Camera: Phoenix ICON (100° FOV). Pediatric retinal photograph (wide-field):
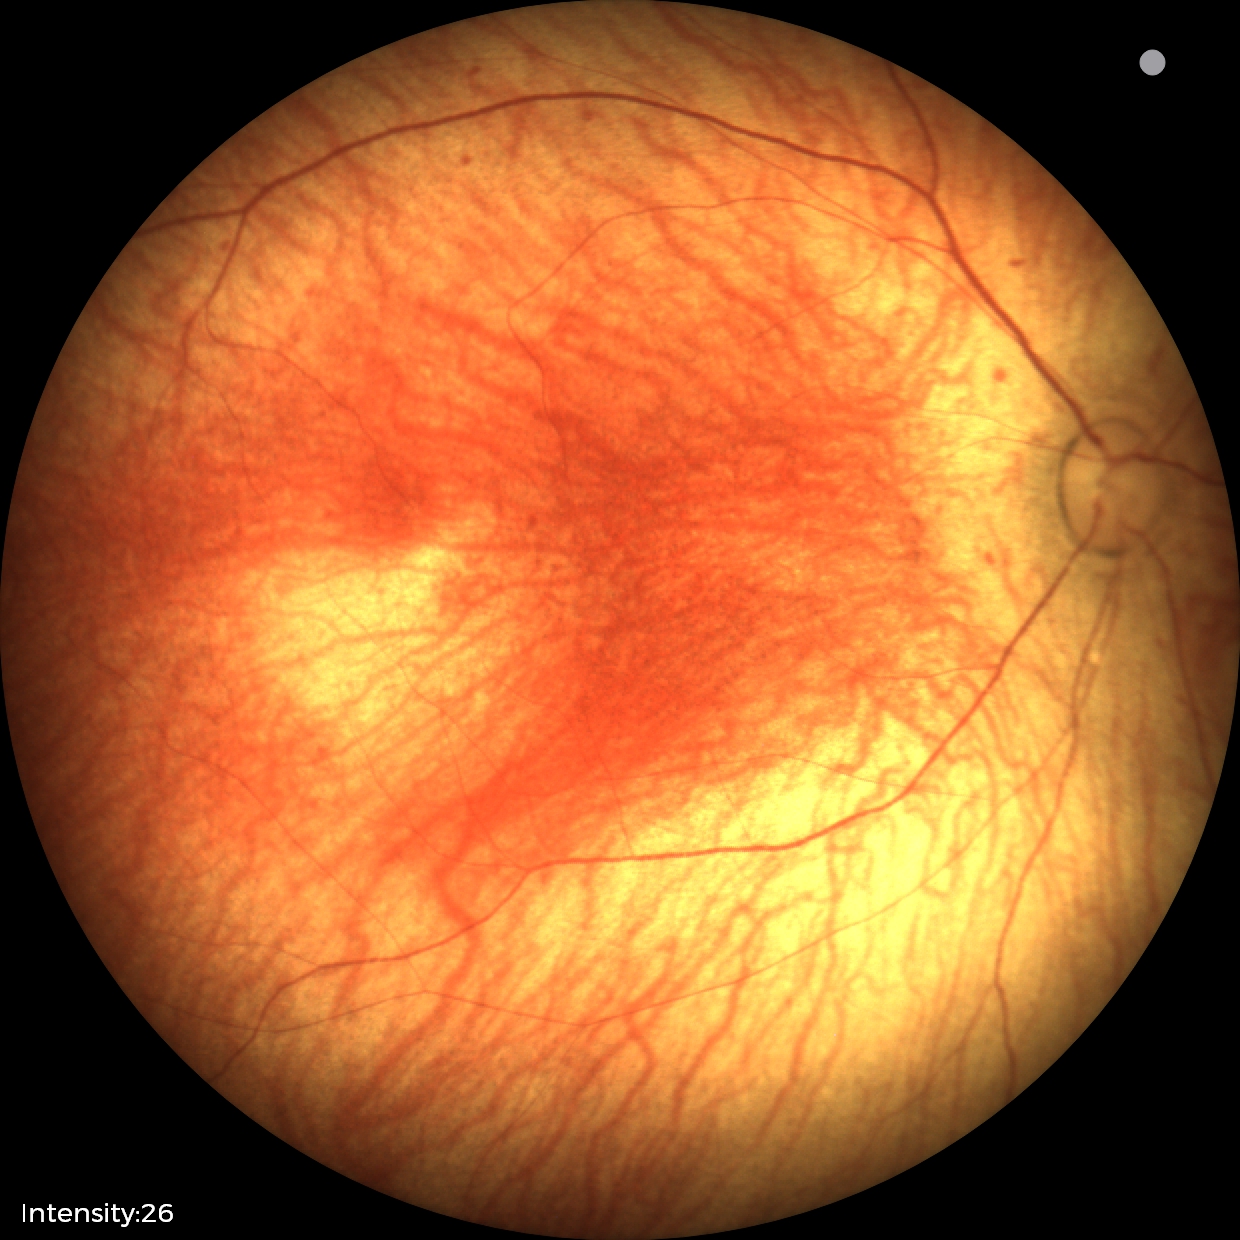
Examination with physiological retinal findings.